Graded on the modified Davis scale: 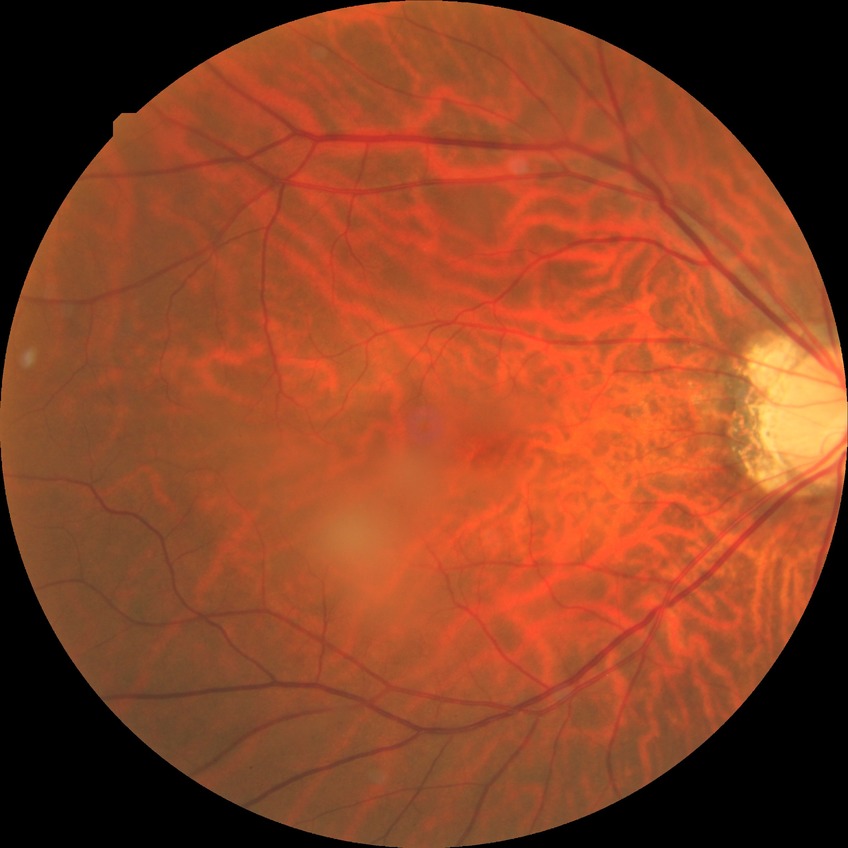 Diabetic retinopathy (DR): NDR (no diabetic retinopathy).